50-degree field of view, pupil-dilated, macula-centered field — 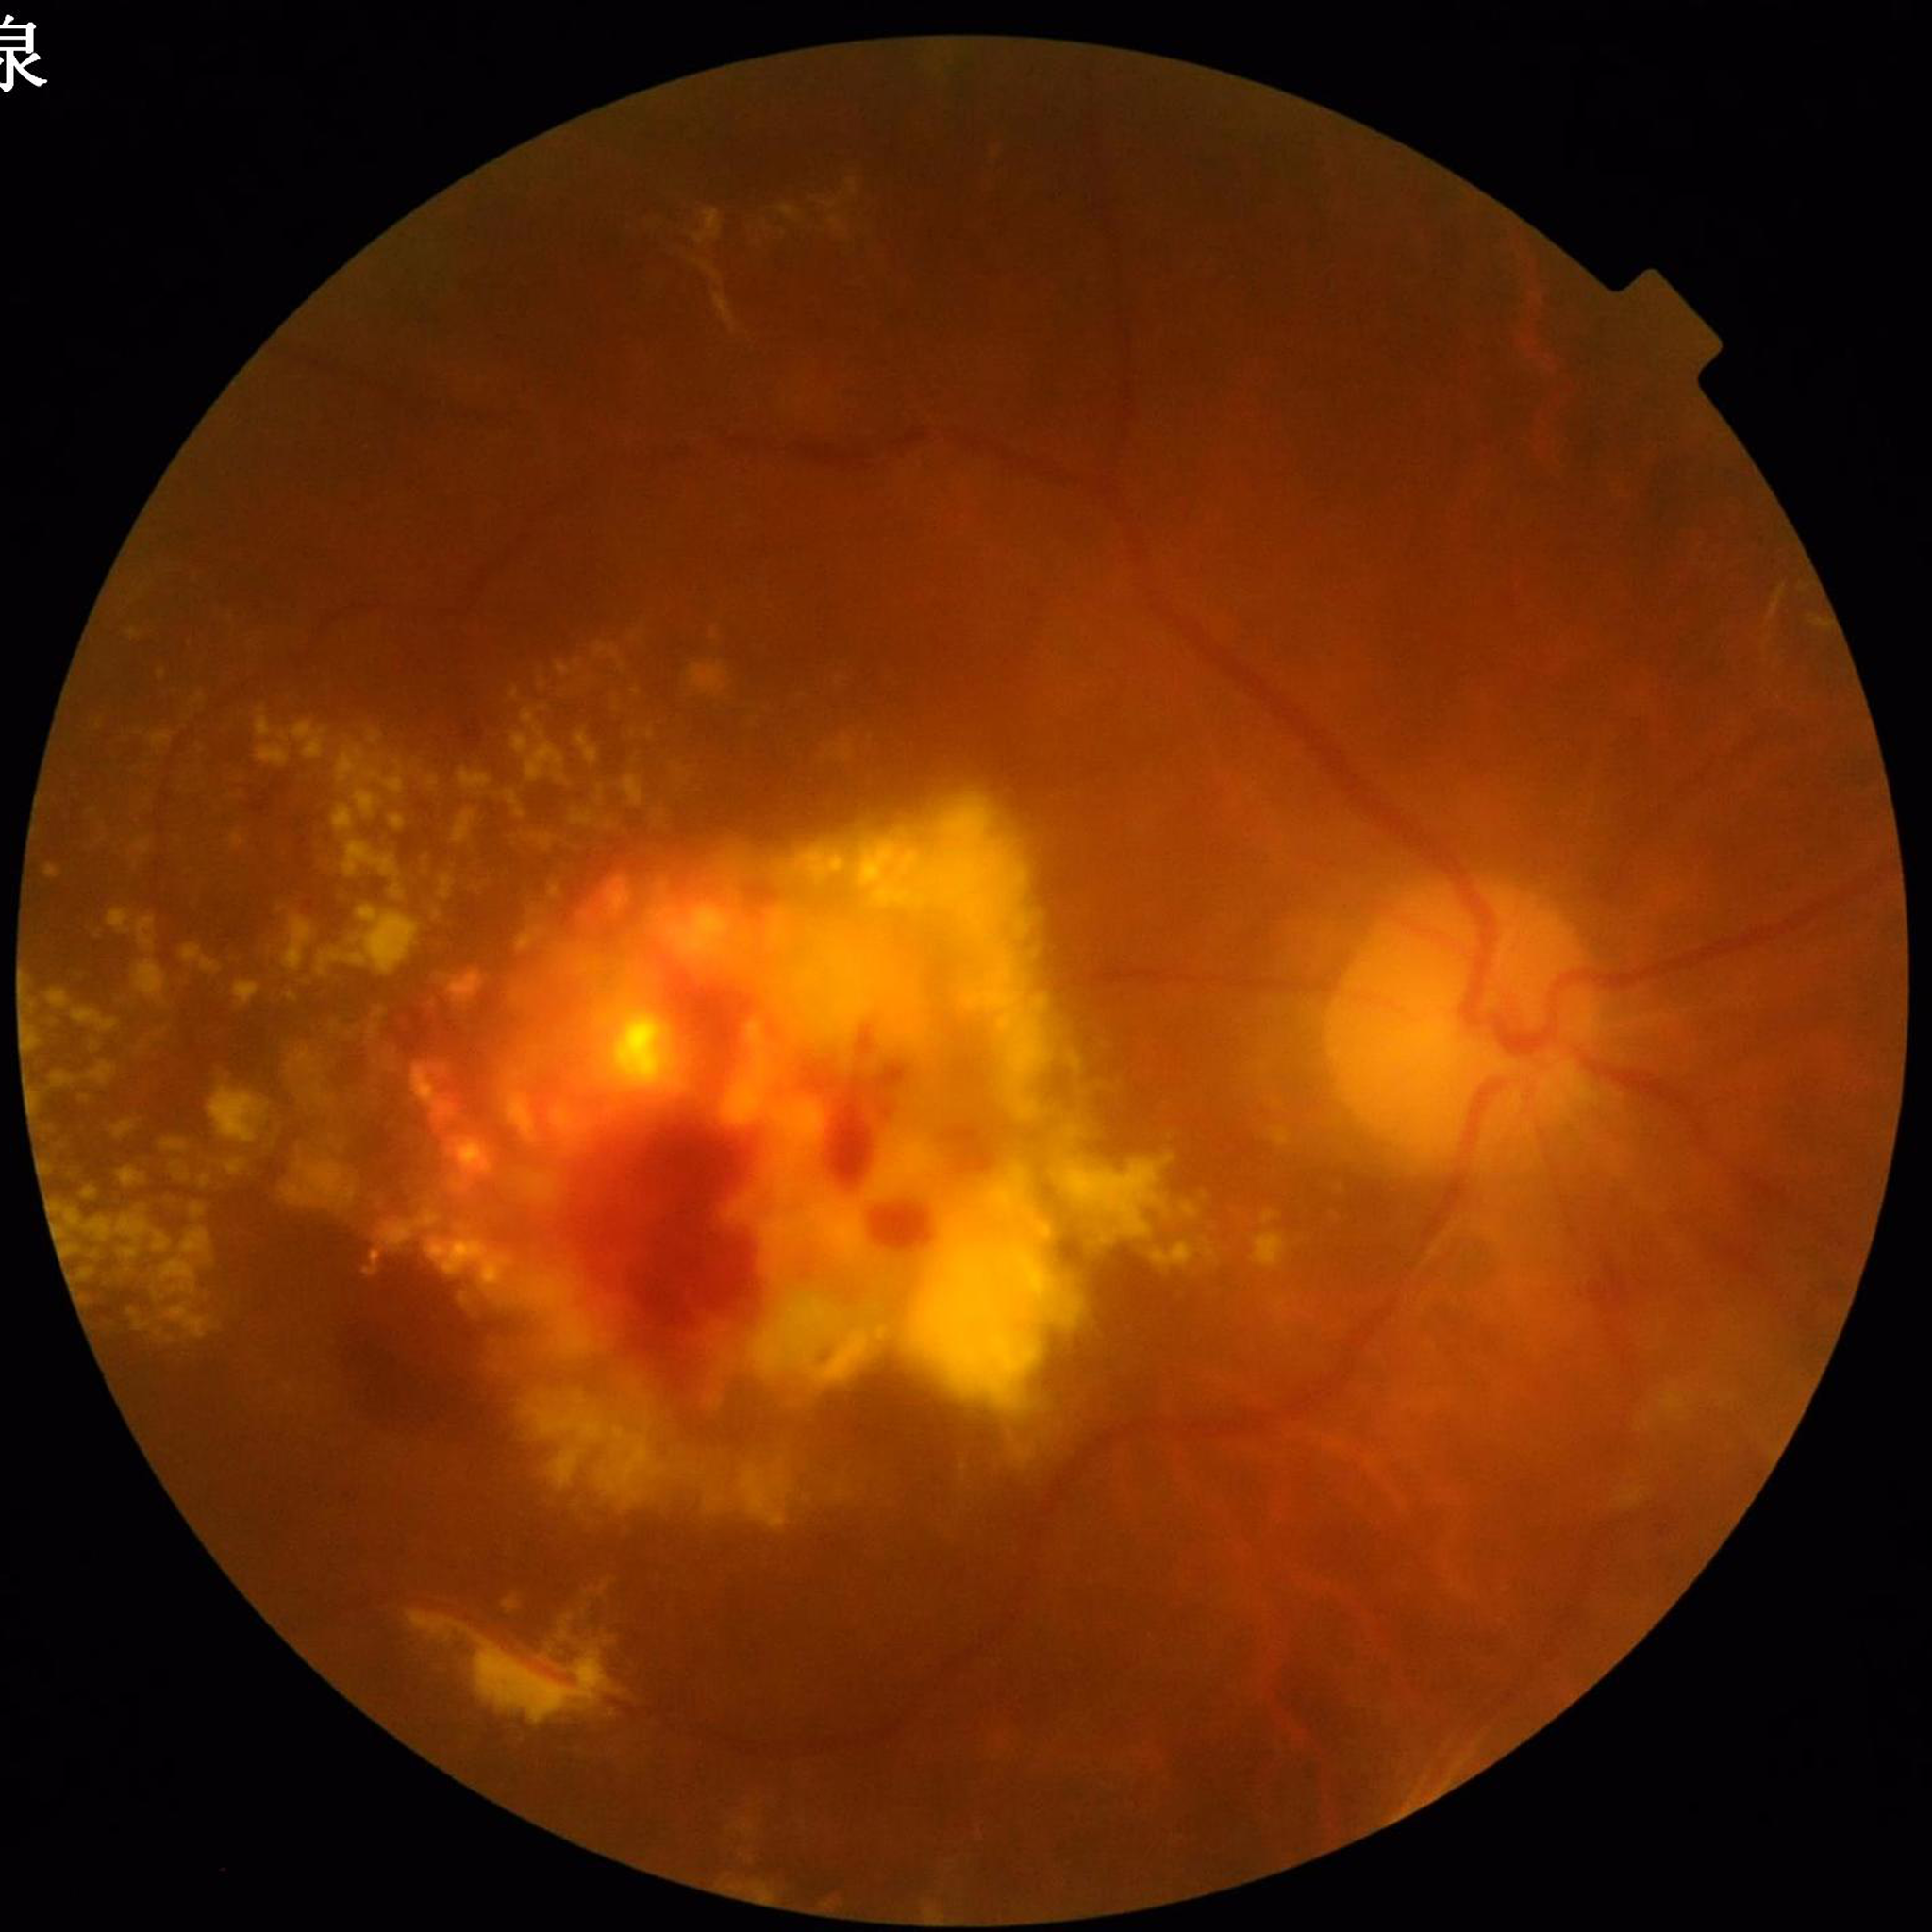

Color fundus photograph from a patient diagnosed with DR. Quality assessment: concerns include blur.